45° field of view:
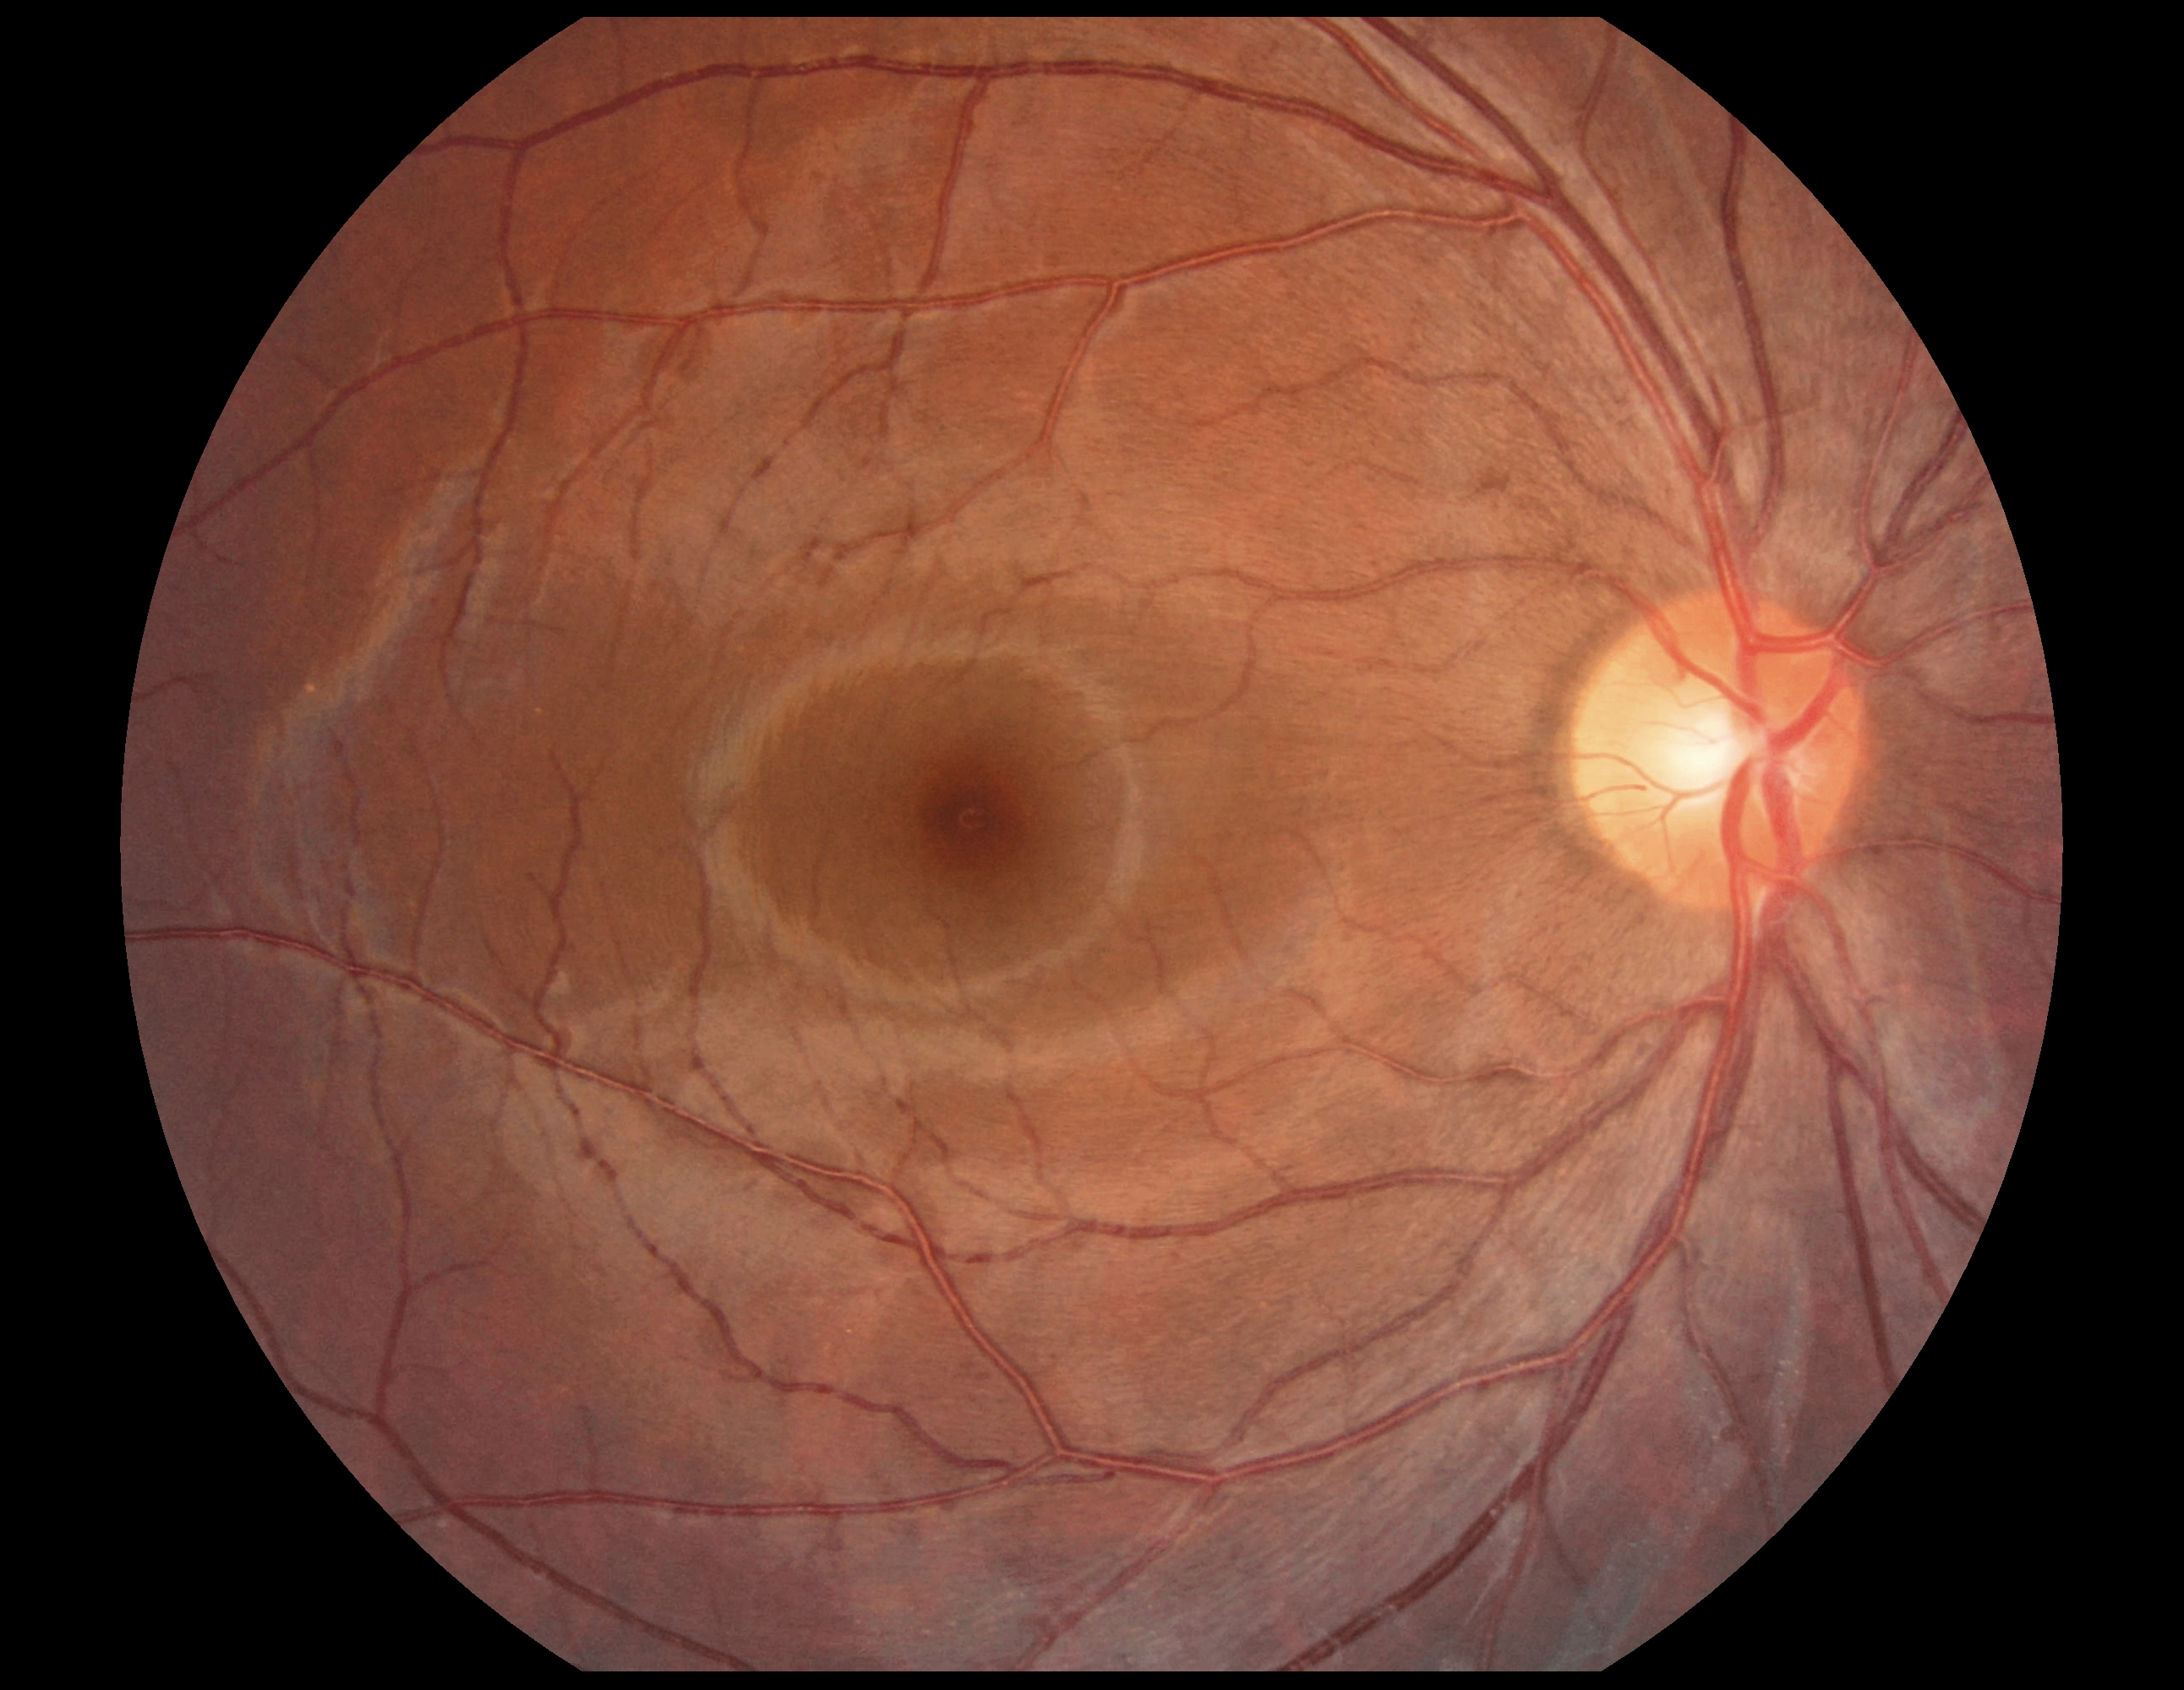

Diabetic retinopathy (DR): no apparent diabetic retinopathy (grade 0) — no visible signs of diabetic retinopathy.